Phoenix ICON, 100° FOV; infant wide-field fundus photograph; image size 1240x1240:
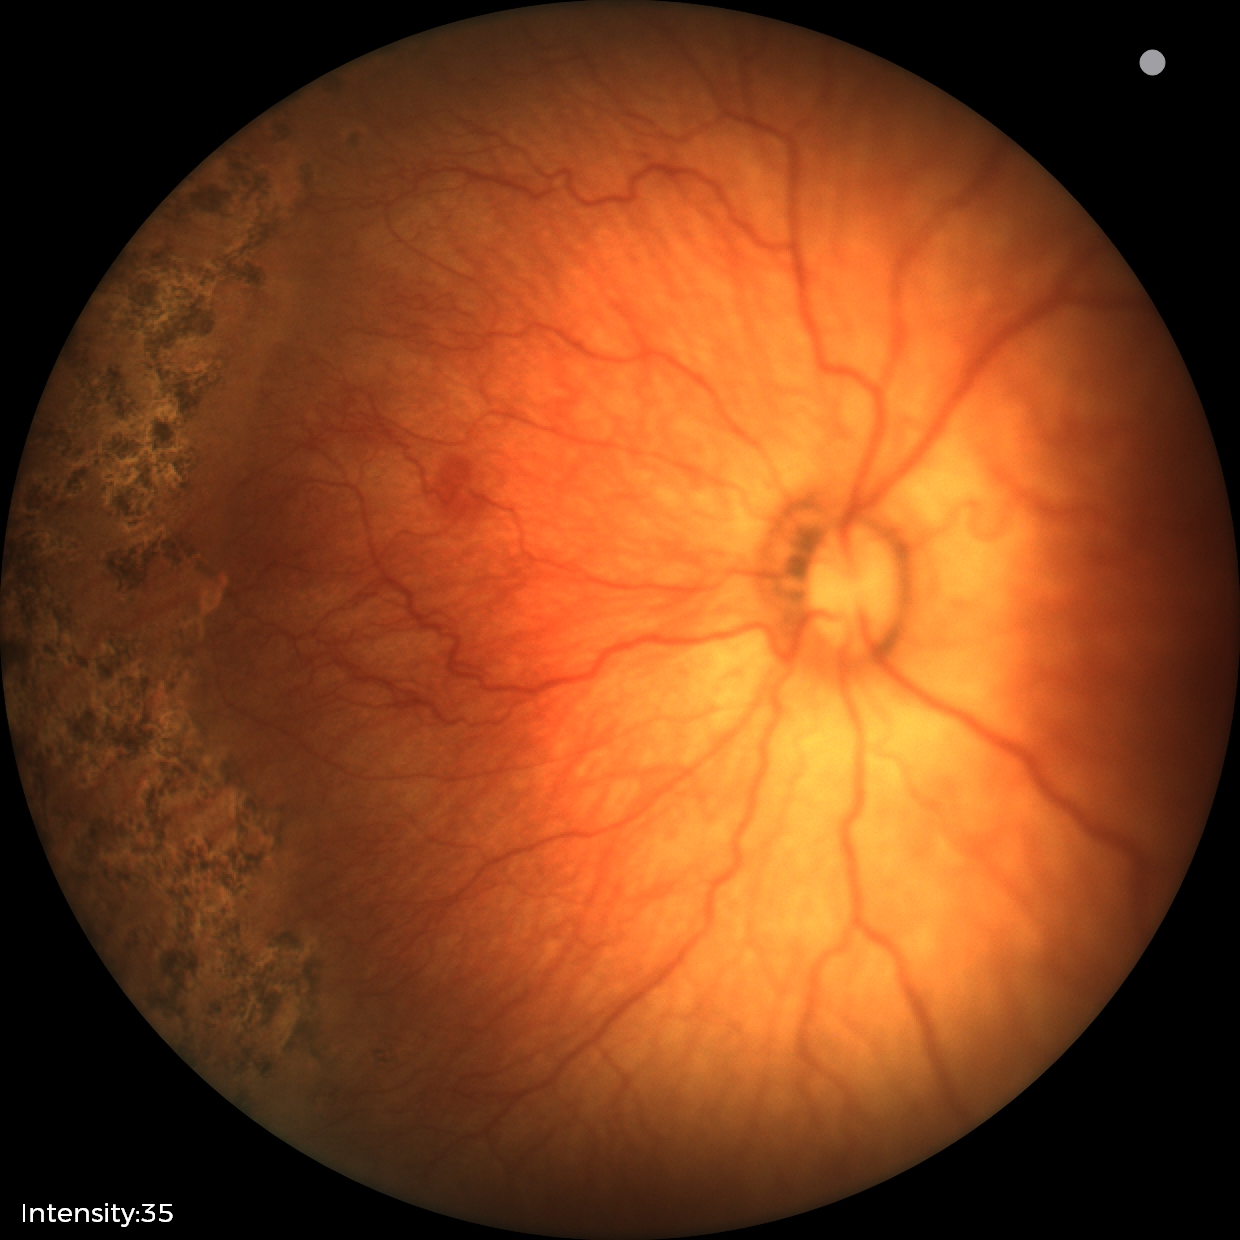

Assessment: retinopathy of prematurity (ROP) stage 1 — demarcation line between vascular and avascular retina; plus disease.